Pediatric wide-field fundus photograph · camera: Clarity RetCam 3 (130° FOV) · image size 640x480.
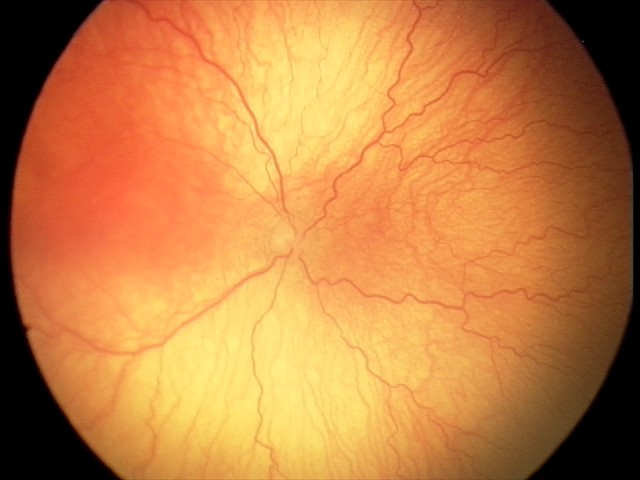

Screening: aggressive retinopathy of prematurity (A-ROP) — rapidly progressive severe ROP with prominent plus disease, often without classic stage progression; plus disease.